45-degree field of view — 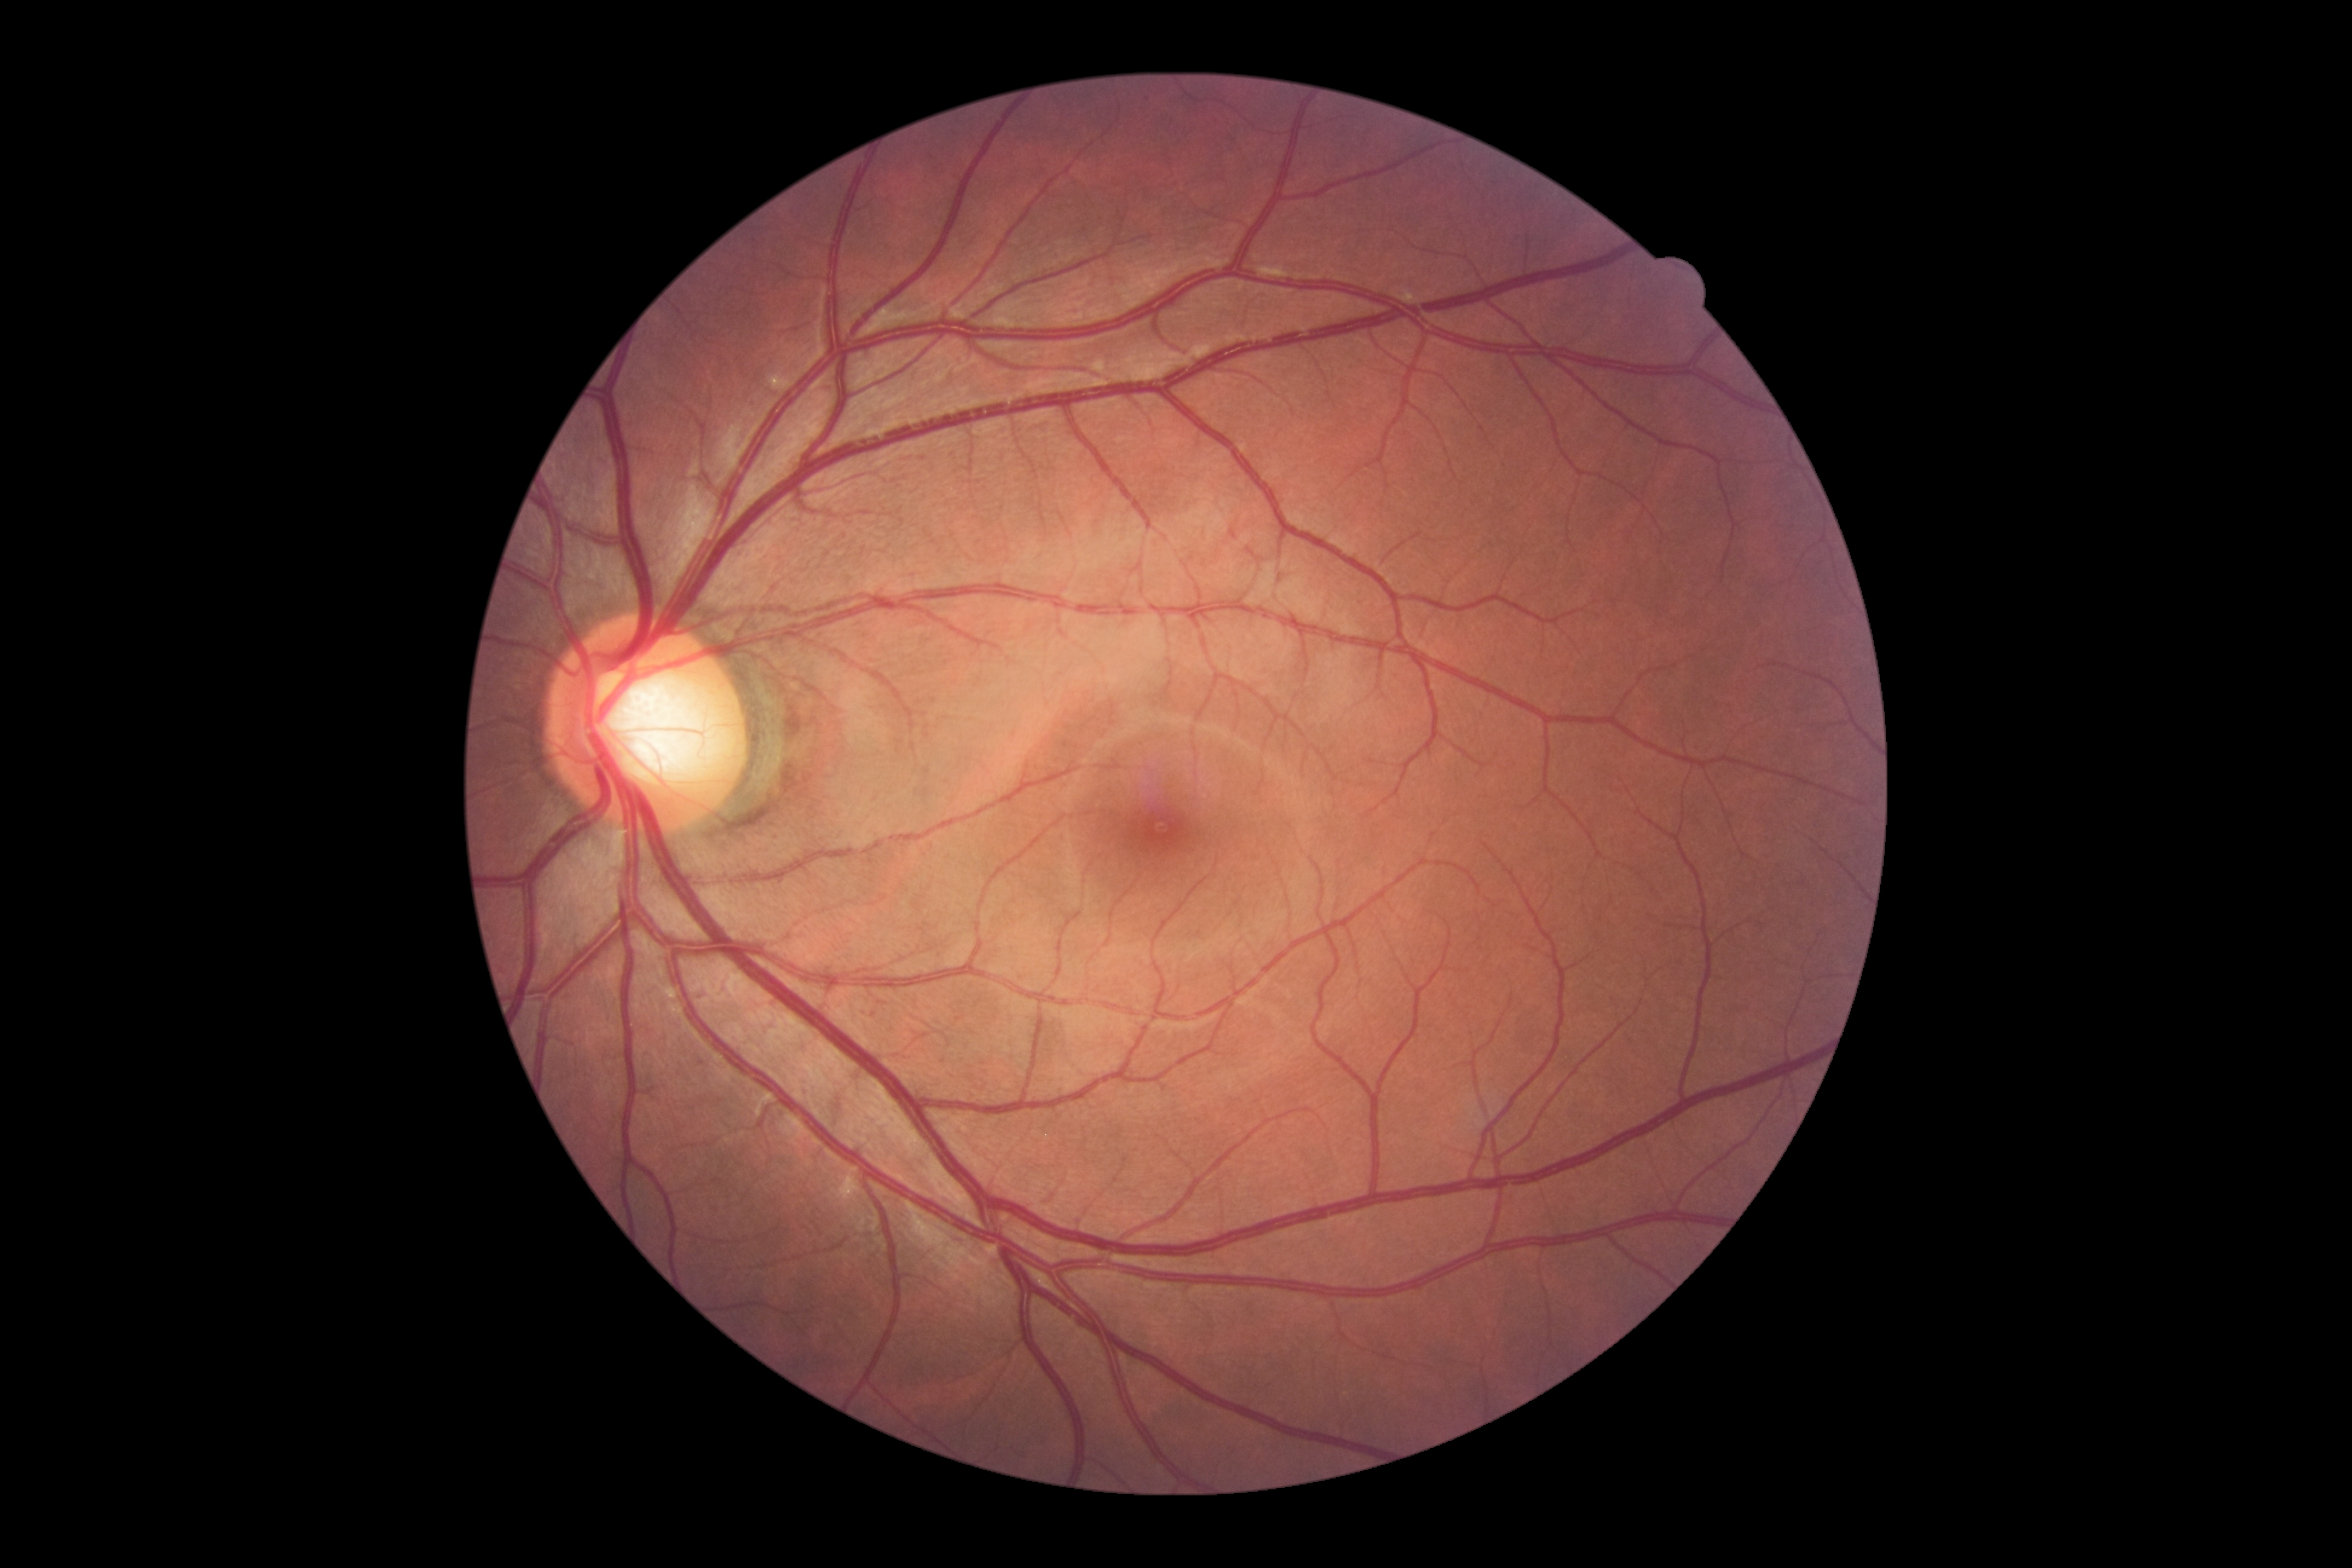
DR stage is no apparent retinopathy (grade 0). No signs of diabetic retinopathy.